45° field of view; 2352 by 1568 pixels
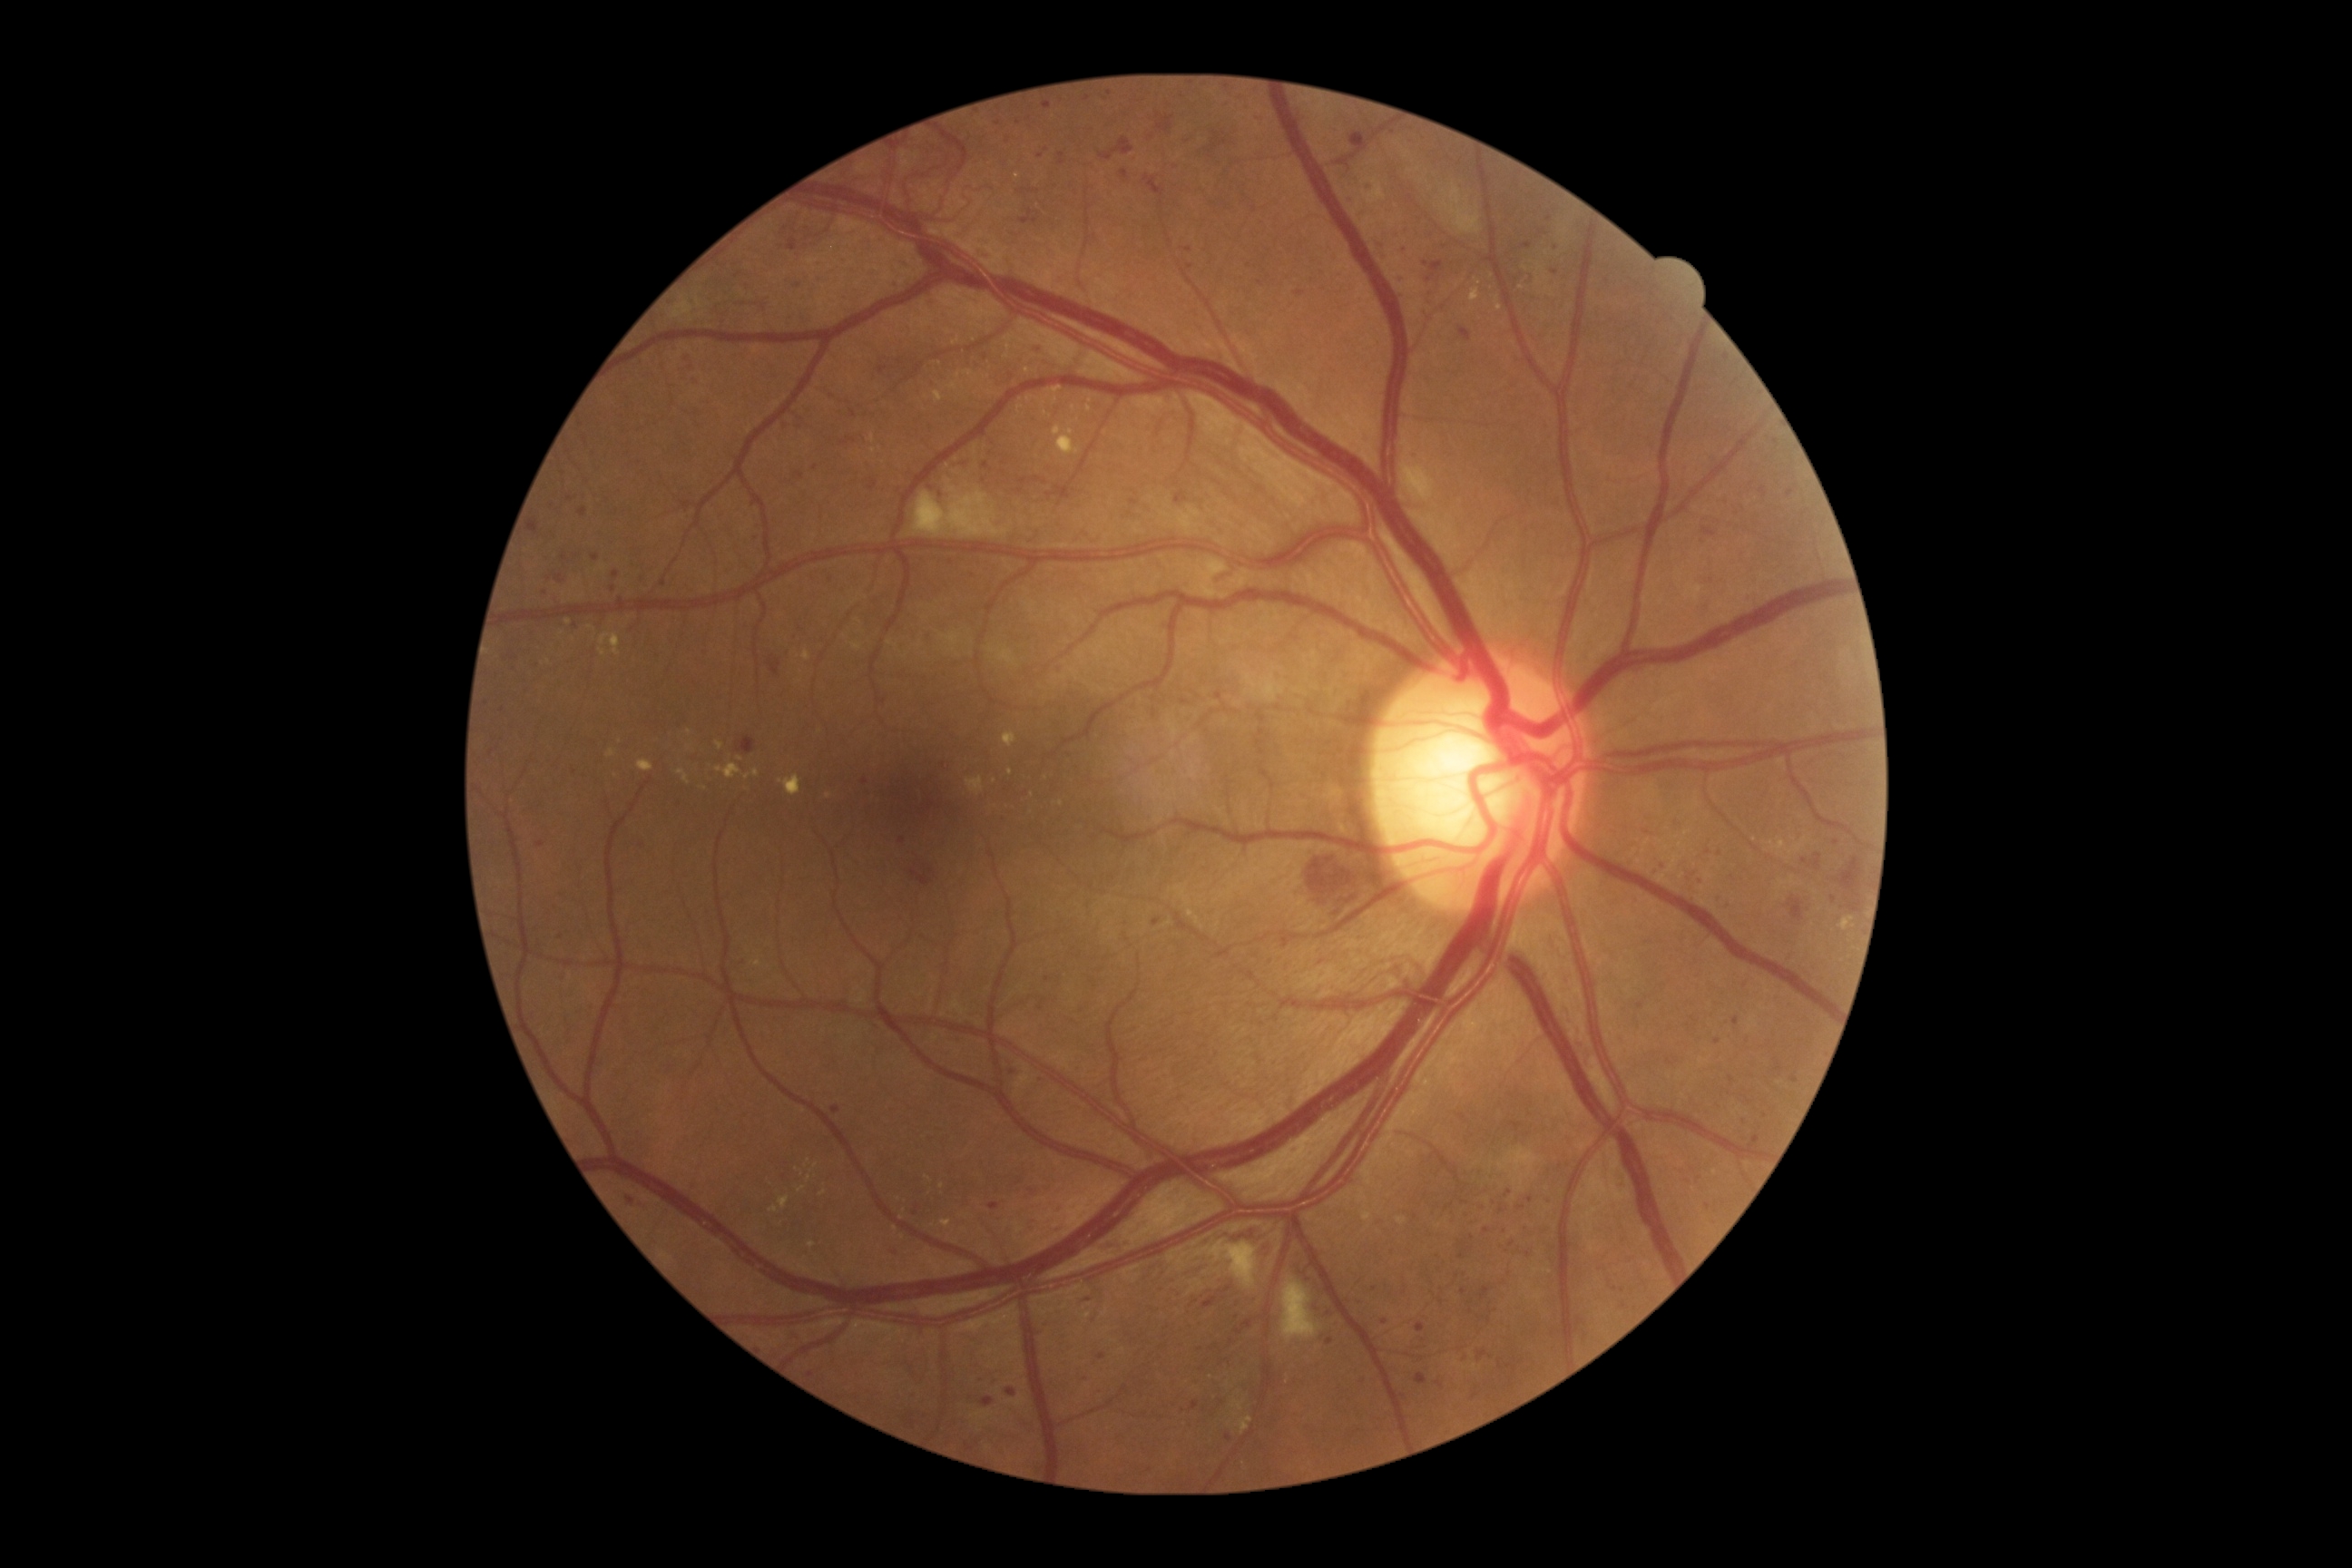
Retinopathy grade is 3 (severe NPDR)
Lesions identified (partial list):
hard exudates (more not shown) = 750,959,763,968 | 769,1208,779,1213 | 1240,1416,1253,1435 | 1057,429,1081,455 | 852,643,863,651 | 1054,426,1063,436 | 1841,917,1854,932
Small hard exudates approximately at {"x": 740, "y": 759} | {"x": 1526, "y": 268} | {"x": 689, "y": 732} | {"x": 1754, "y": 839} | {"x": 1089, "y": 409} | {"x": 1046, "y": 414} | {"x": 1061, "y": 804} | {"x": 903, "y": 1237} | {"x": 1478, "y": 282} | {"x": 689, "y": 748} | {"x": 873, "y": 450}
soft exudates = 912,487,1010,538 | 1282,1279,1322,1342 | 1442,186,1482,235 | 1204,1240,1259,1289
microaneurysms (more not shown) = 1478,1351,1487,1358 | 792,1328,803,1340 | 1426,289,1435,295 | 1424,306,1433,315 | 1427,262,1444,282 | 754,534,761,544 | 612,573,620,580 | 1511,1122,1522,1132 | 1415,1322,1426,1333
Small microaneurysms approximately at {"x": 1721, "y": 899} | {"x": 798, "y": 286} | {"x": 1041, "y": 157} | {"x": 1687, "y": 1182} | {"x": 1008, "y": 141} | {"x": 1413, "y": 452} | {"x": 1227, "y": 102} | {"x": 1020, "y": 1182} | {"x": 1682, "y": 1170} | {"x": 1384, "y": 1323} | {"x": 1708, "y": 852}
hemorrhages (more not shown) = 738,736,756,754 | 1220,1286,1233,1295 | 1237,1231,1268,1257 | 1017,190,1026,195 | 910,870,932,887 | 681,357,692,366 | 1121,170,1128,181 | 767,656,781,676 | 1144,175,1166,197 | 691,375,700,389 | 1812,854,1823,870 | 1206,132,1228,155 | 1308,856,1364,916
Small hemorrhages approximately at {"x": 1021, "y": 492}